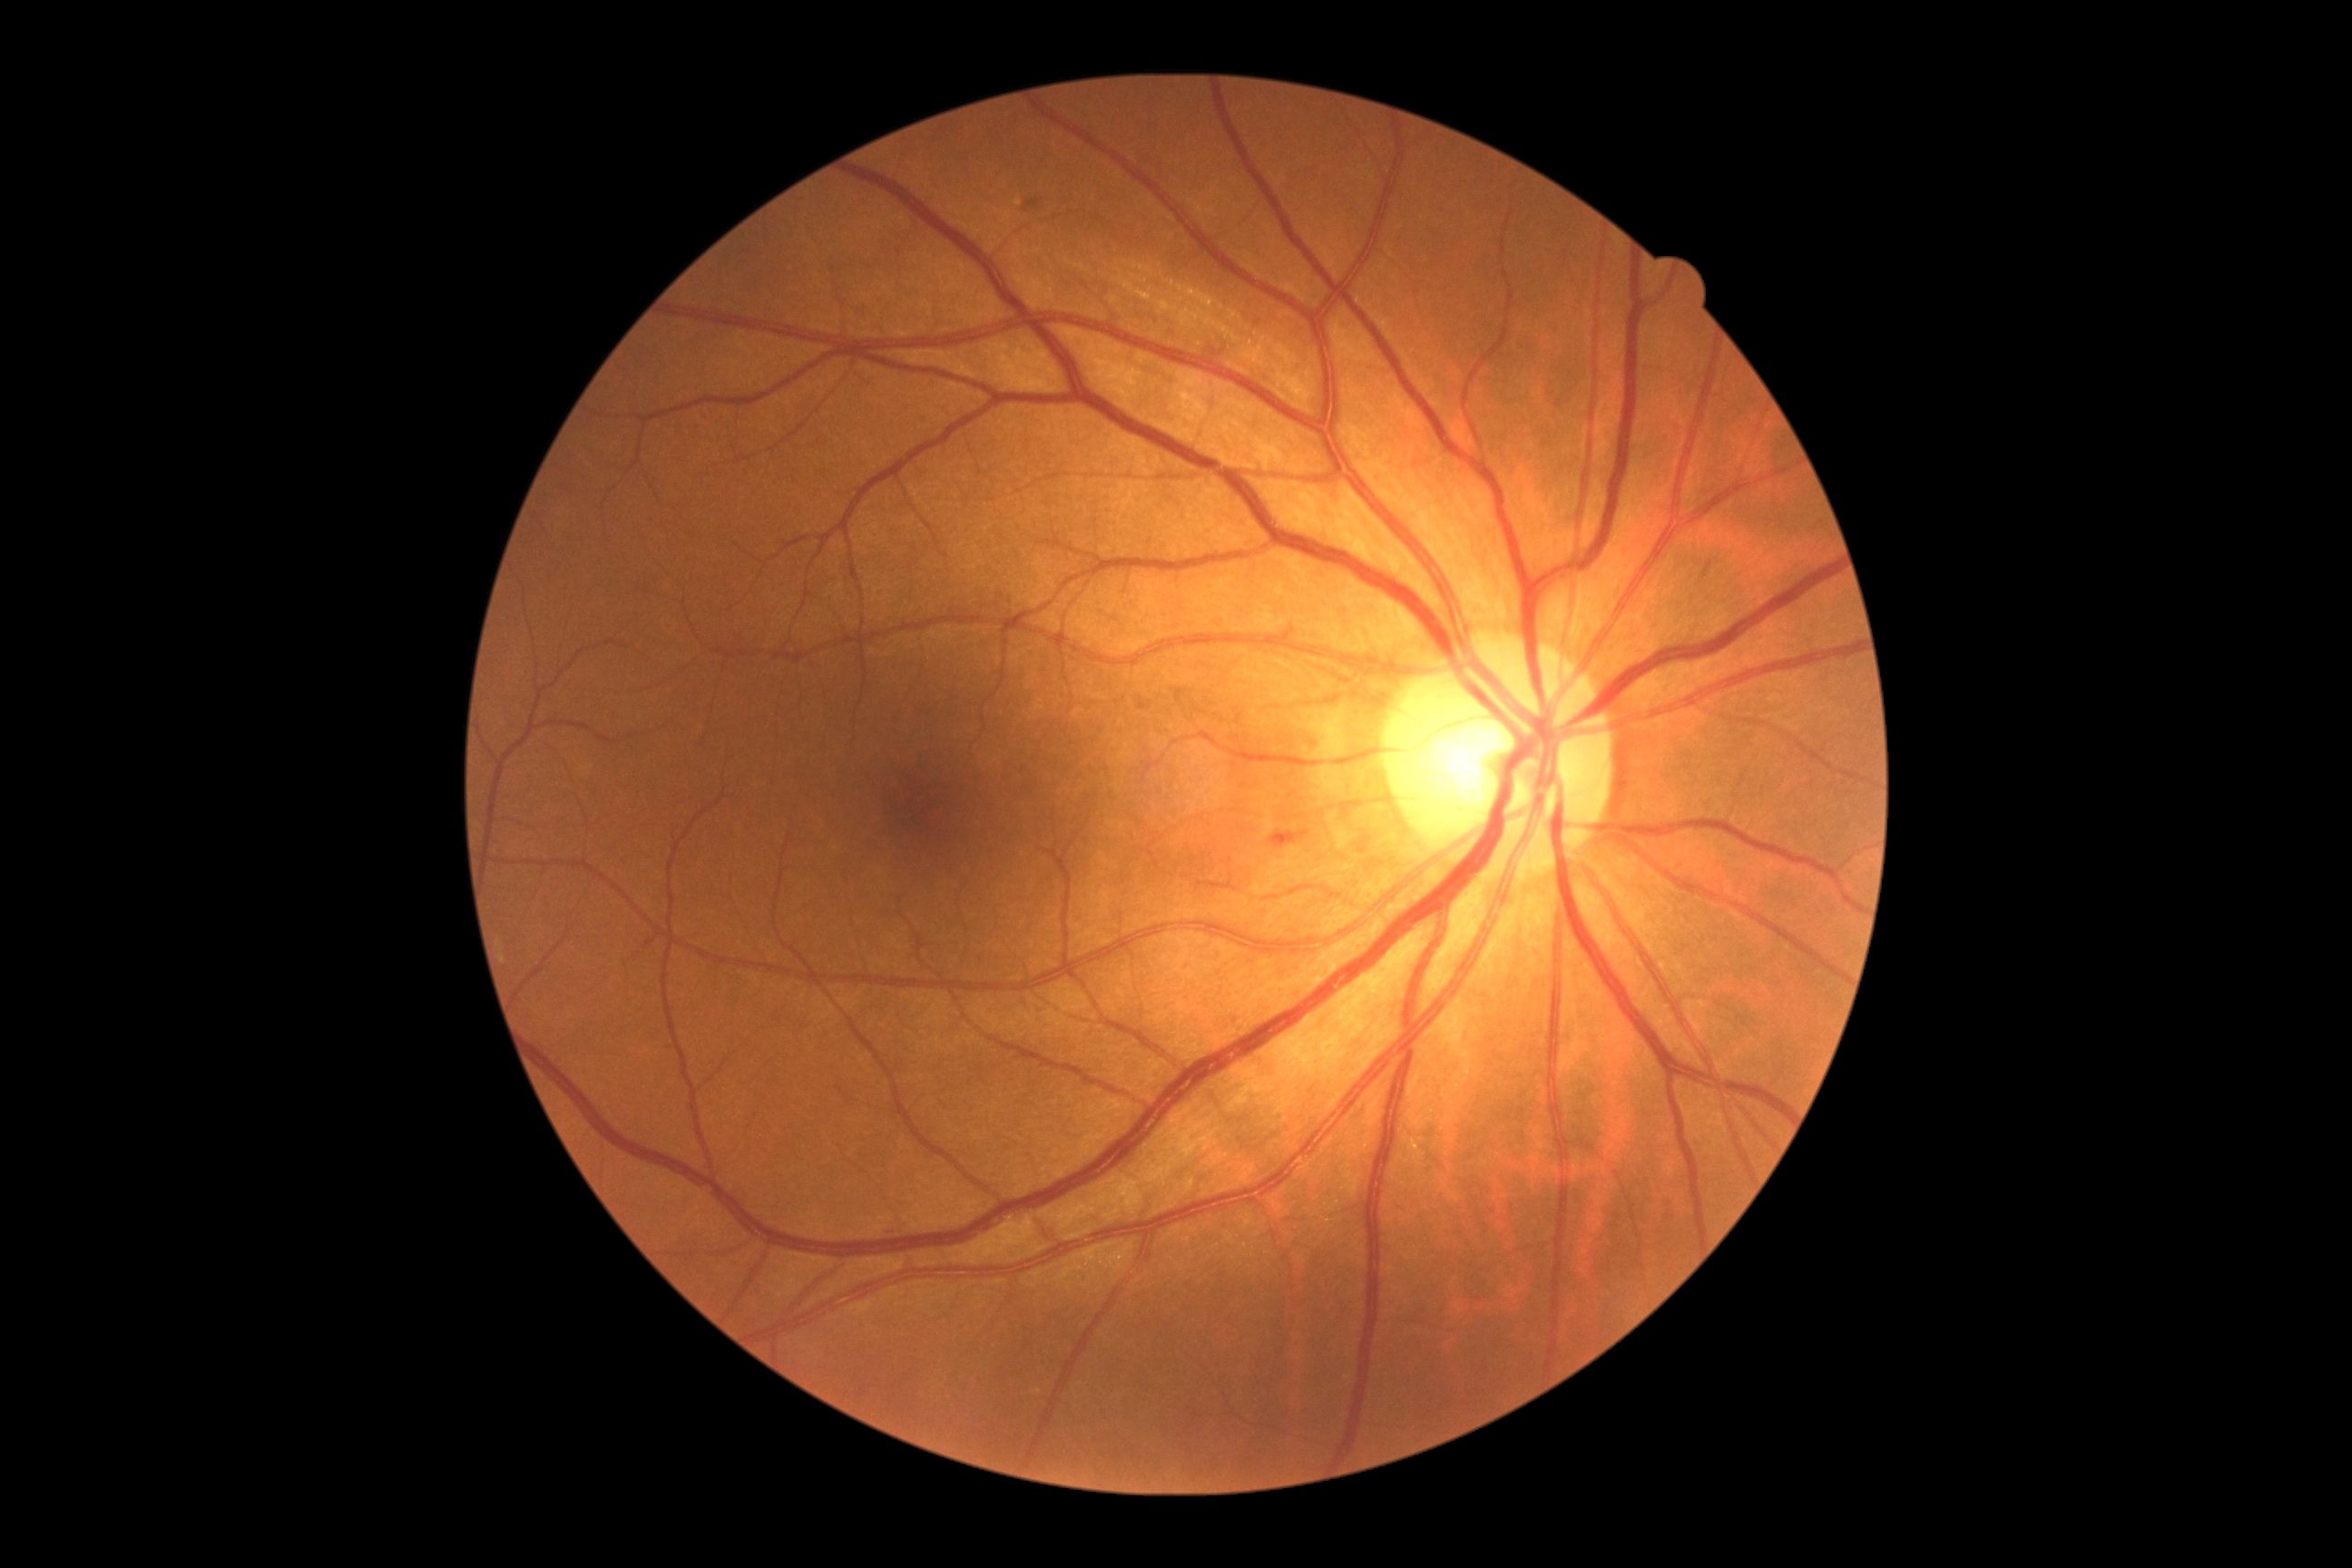
Retinopathy: moderate non-proliferative diabetic retinopathy (grade 2)
hard exudates: none detected
hemorrhages: [1703, 562, 1714, 580]; [883, 1230, 894, 1235]; [1273, 830, 1308, 843]
microaneurysms: none detected
soft exudates: none detected